Diabetic retinopathy graded by the modified Davis classification · image size 848x848.
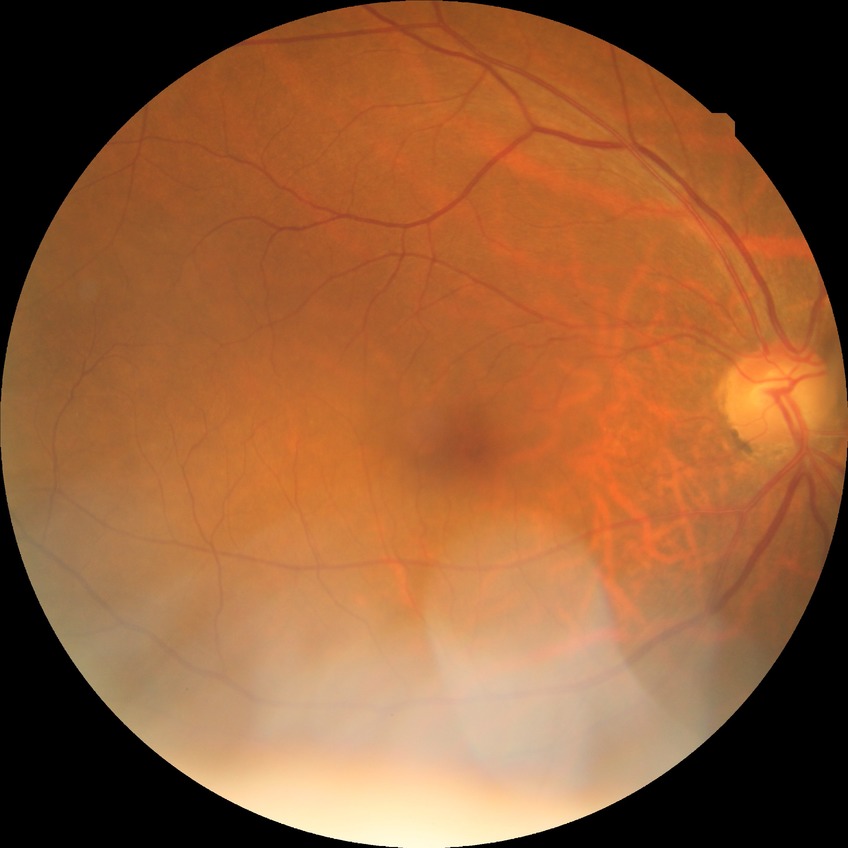
Diabetic retinopathy (DR): no diabetic retinopathy (NDR).